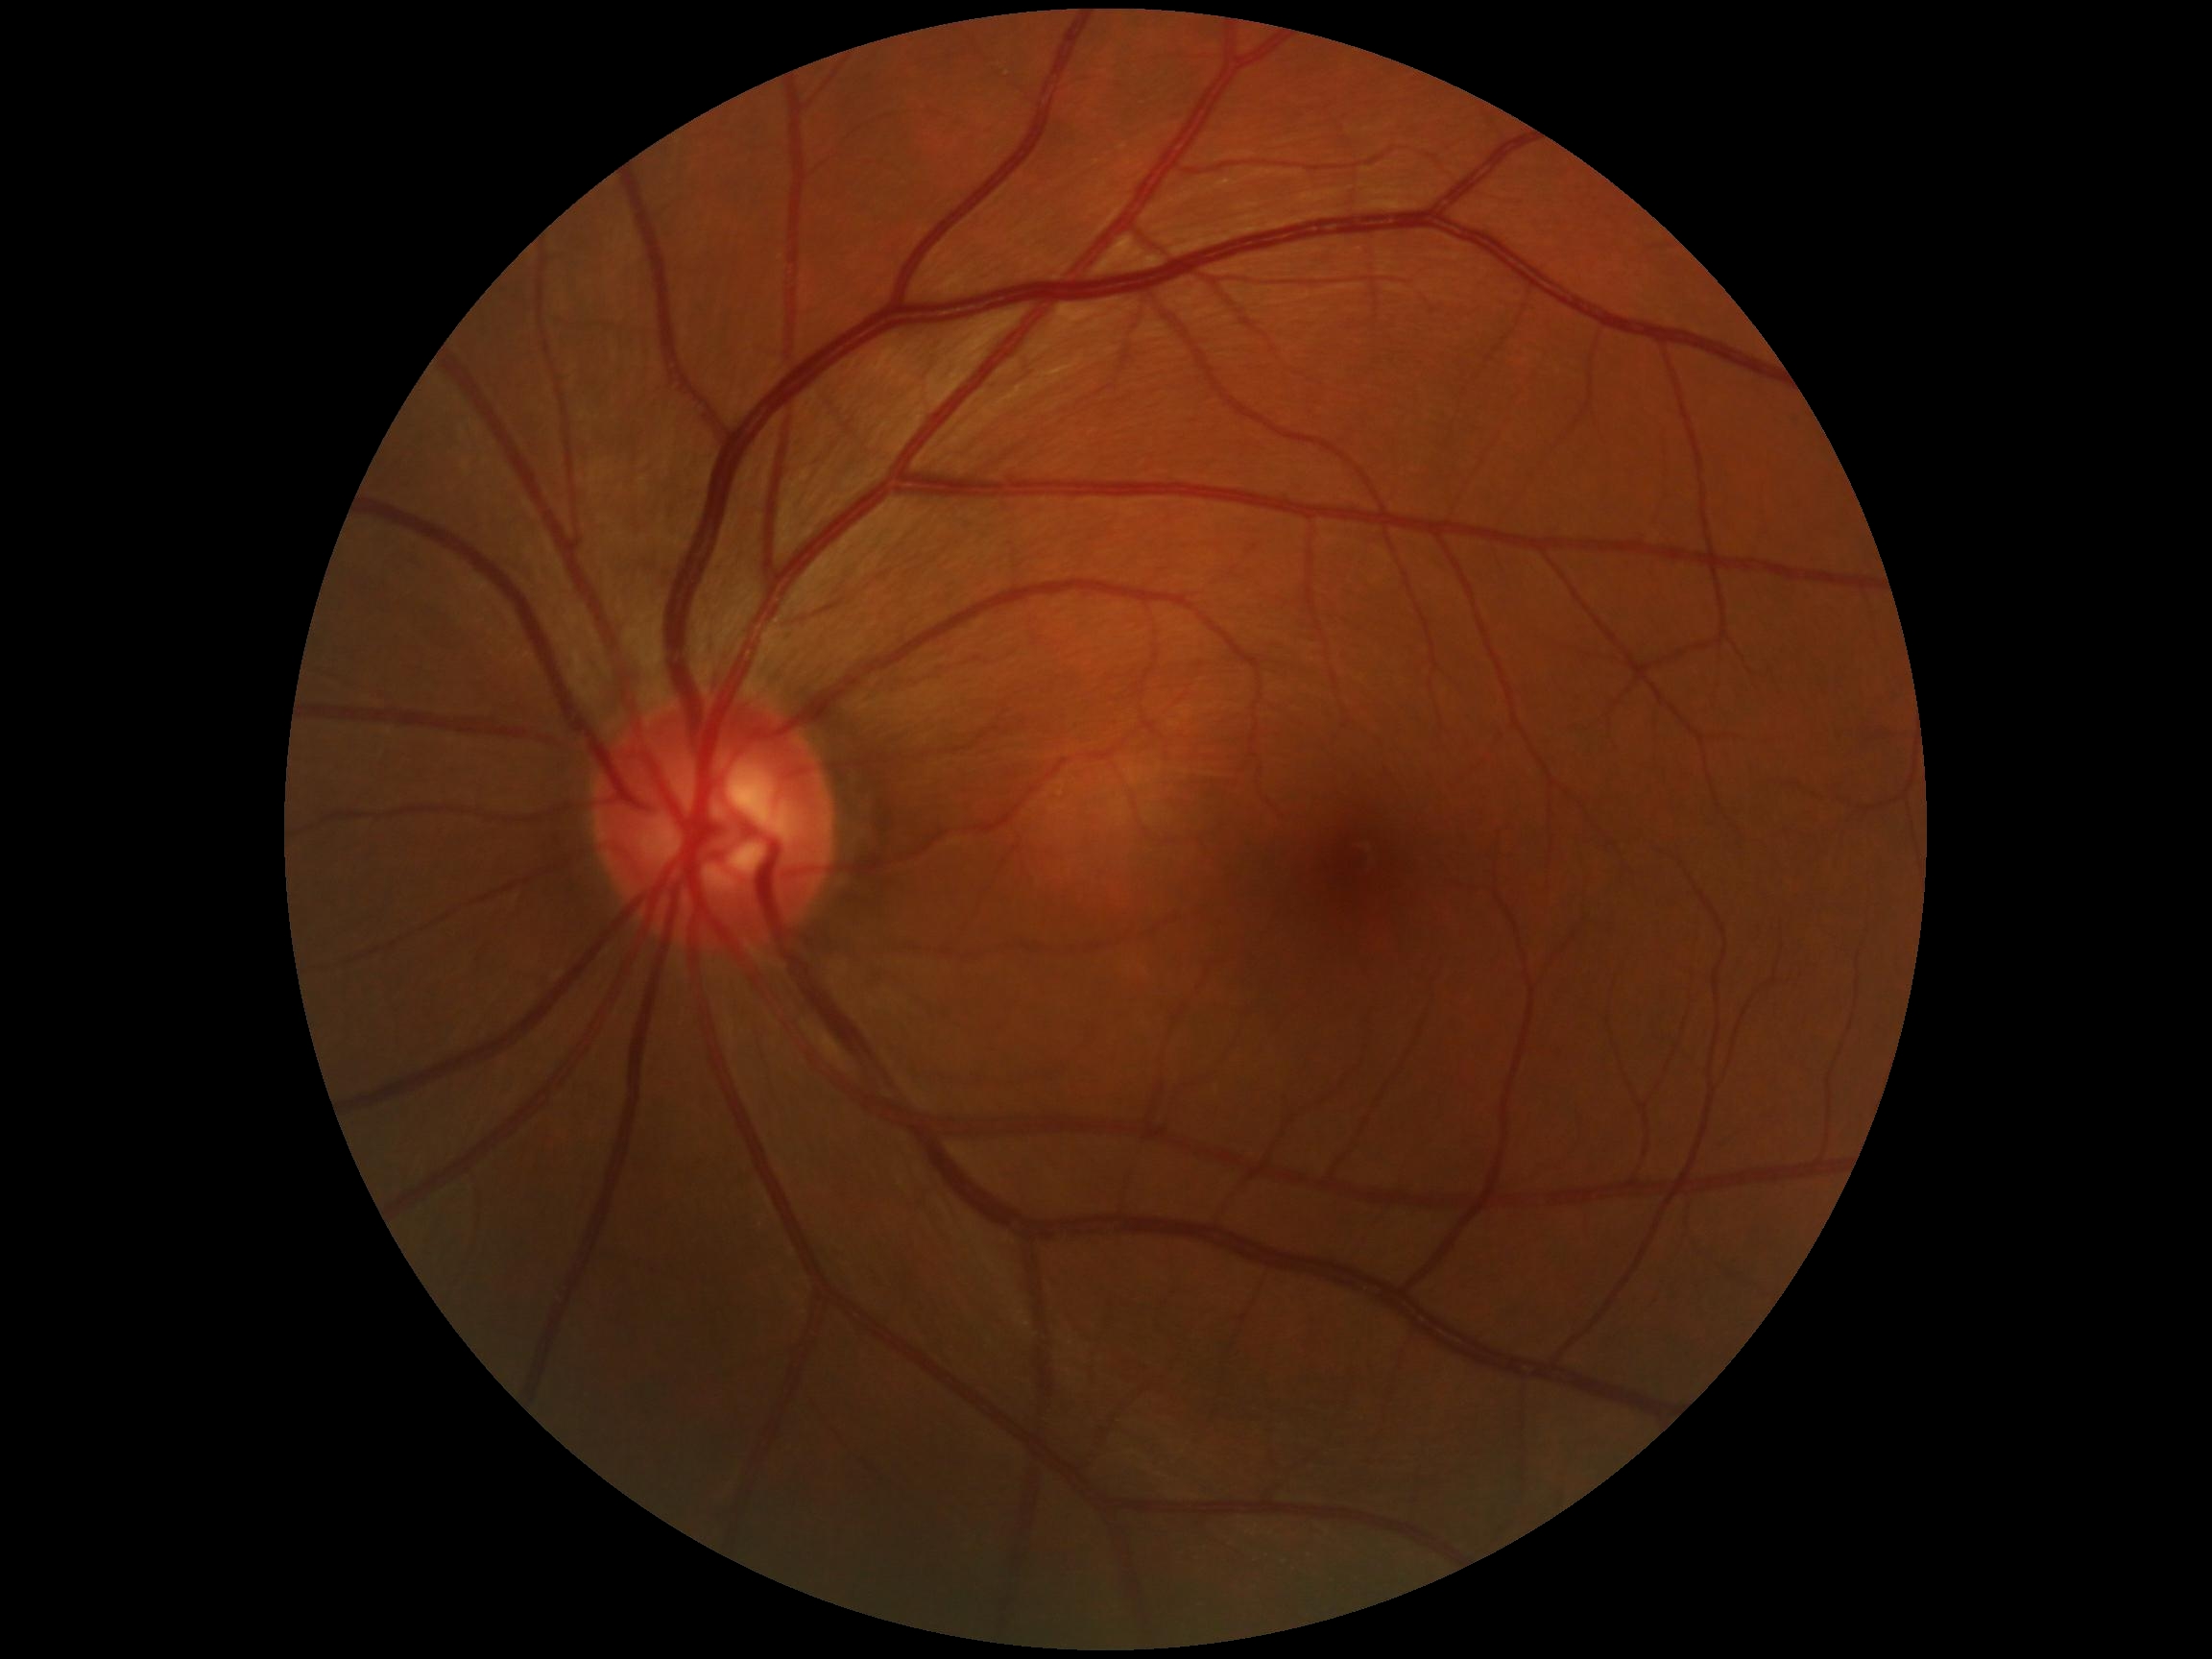 Findings:
- retinopathy — grade 0 (no apparent retinopathy)